Wide-field fundus photograph from neonatal ROP screening: 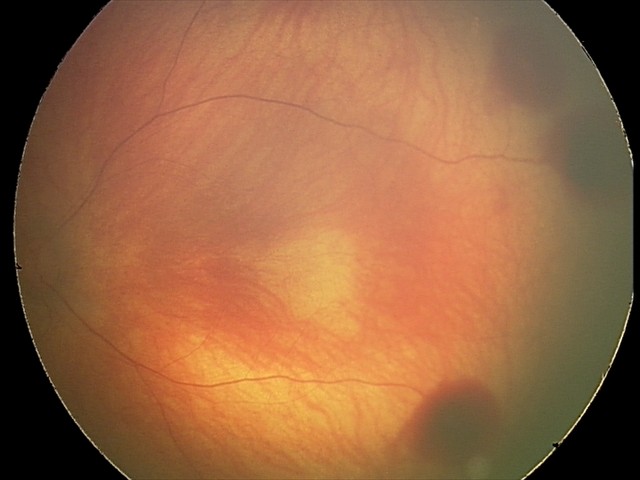 From an examination with diagnosis of retinal hemorrhages.